Color fundus photograph.
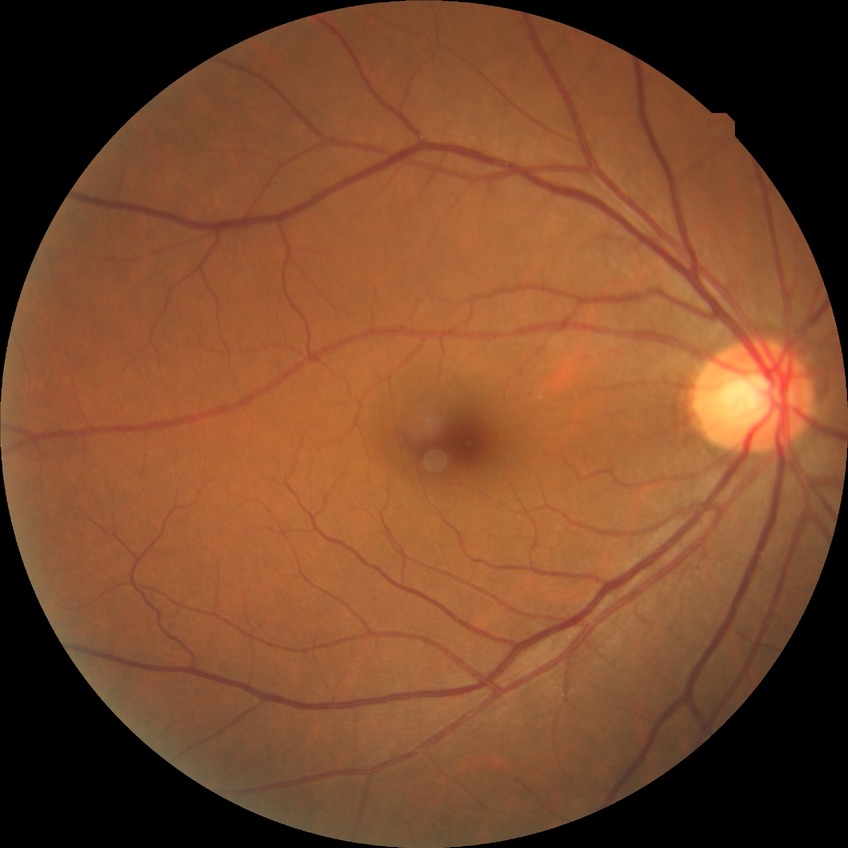

diabetic retinopathy (DR) = no diabetic retinopathy (NDR).